45° field of view: 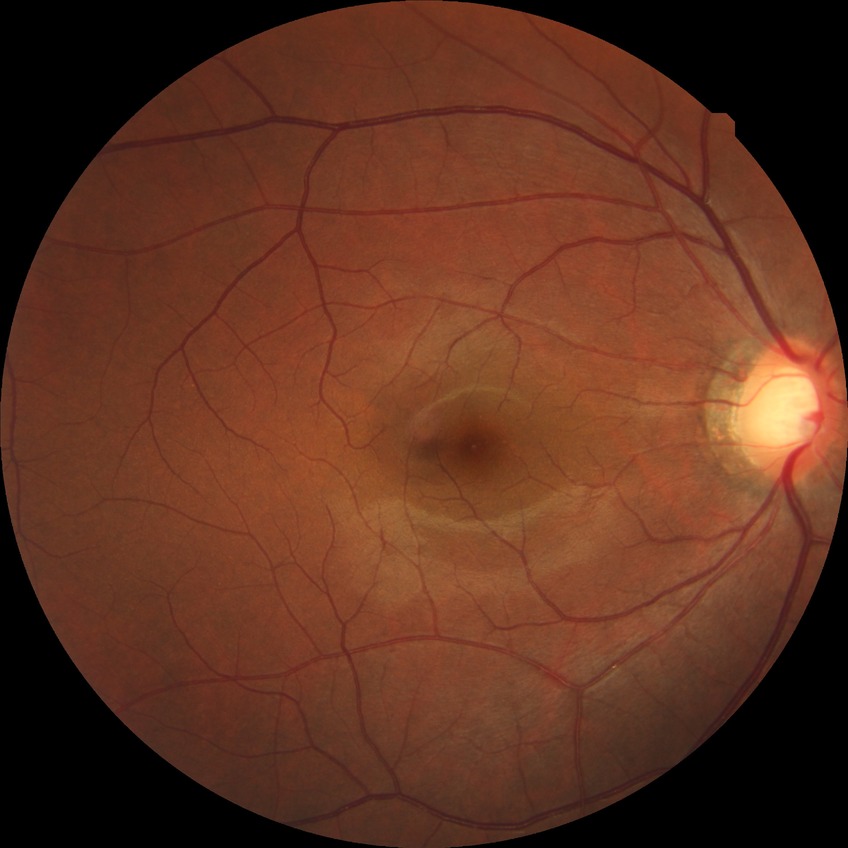
No DR findings.
DR is NDR.